Non-mydriatic — 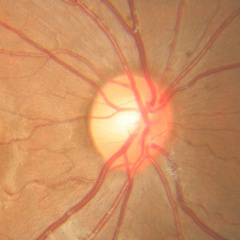
Q: What is the glaucoma diagnosis?
A: No signs of glaucoma.